NIDEK AFC-230 · DR severity per modified Davis staging
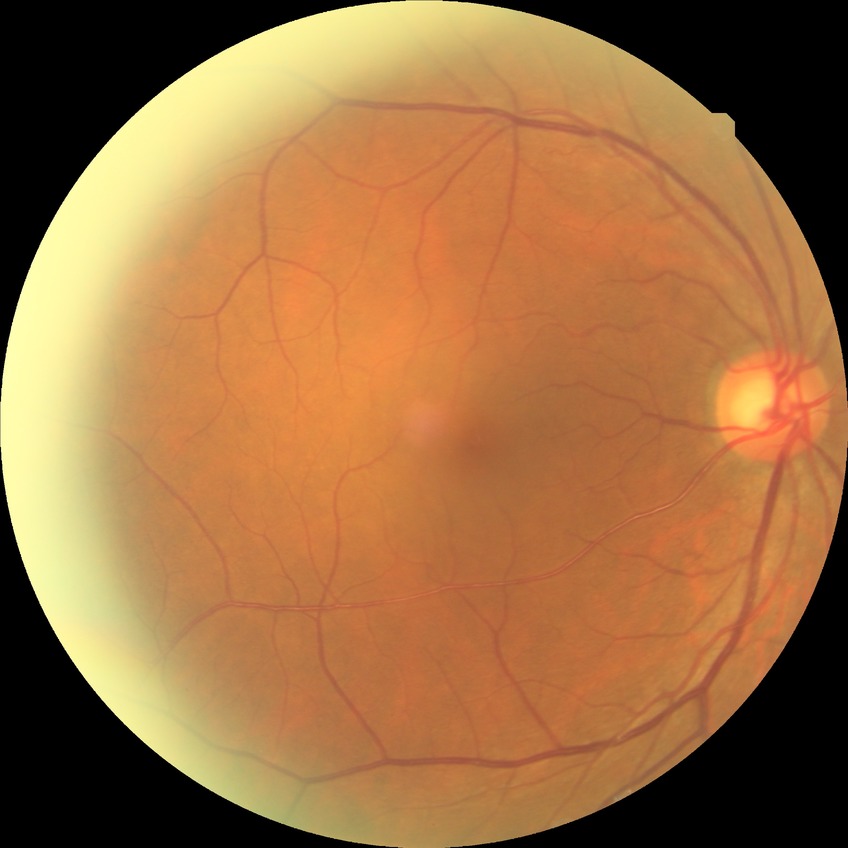

Annotations:
- retinopathy grade: no diabetic retinopathy